2361 x 1568 pixels, fundus photo, camera: Kowa VX-10α, macula at the center of the field
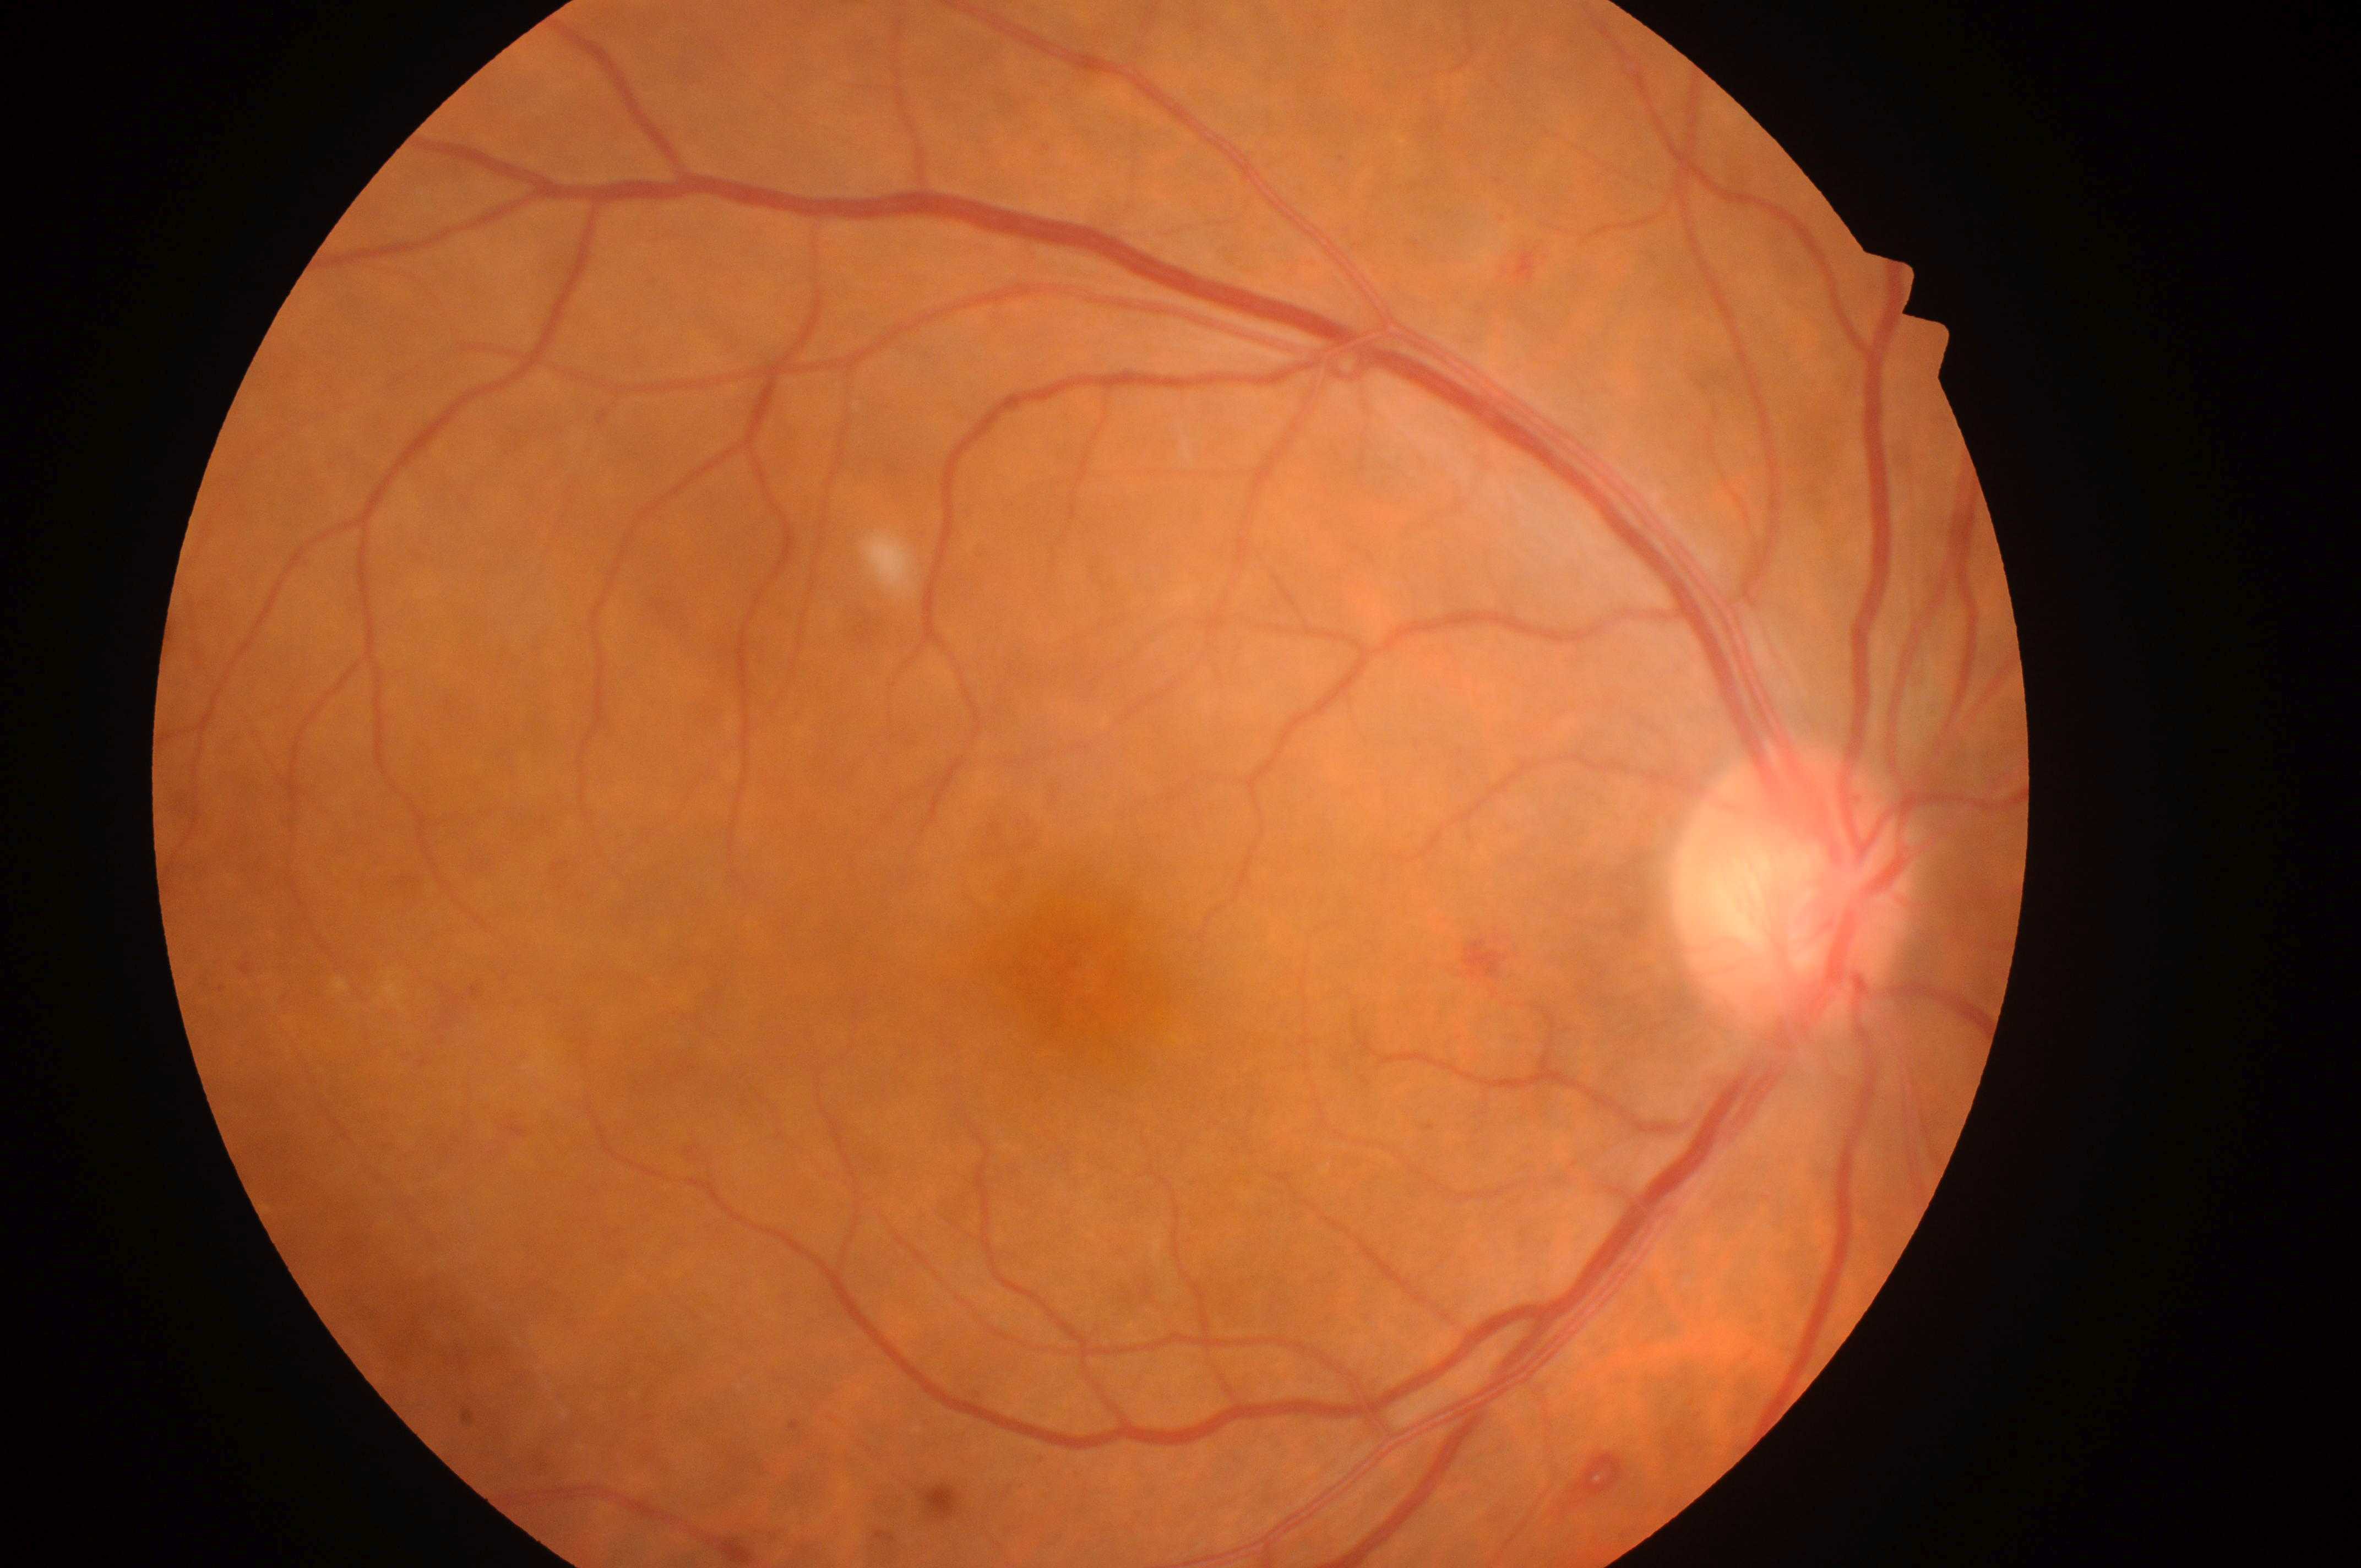
ONH: (1794, 897).
Fovea located at (1070, 981).
Imaged eye: the right eye.
Retinopathy: proliferative diabetic retinopathy (grade 4) — neovascularization and/or vitreous/pre-retinal hemorrhage.
Diabetic macular edema: no risk (grade 0) — no apparent hard exudates.